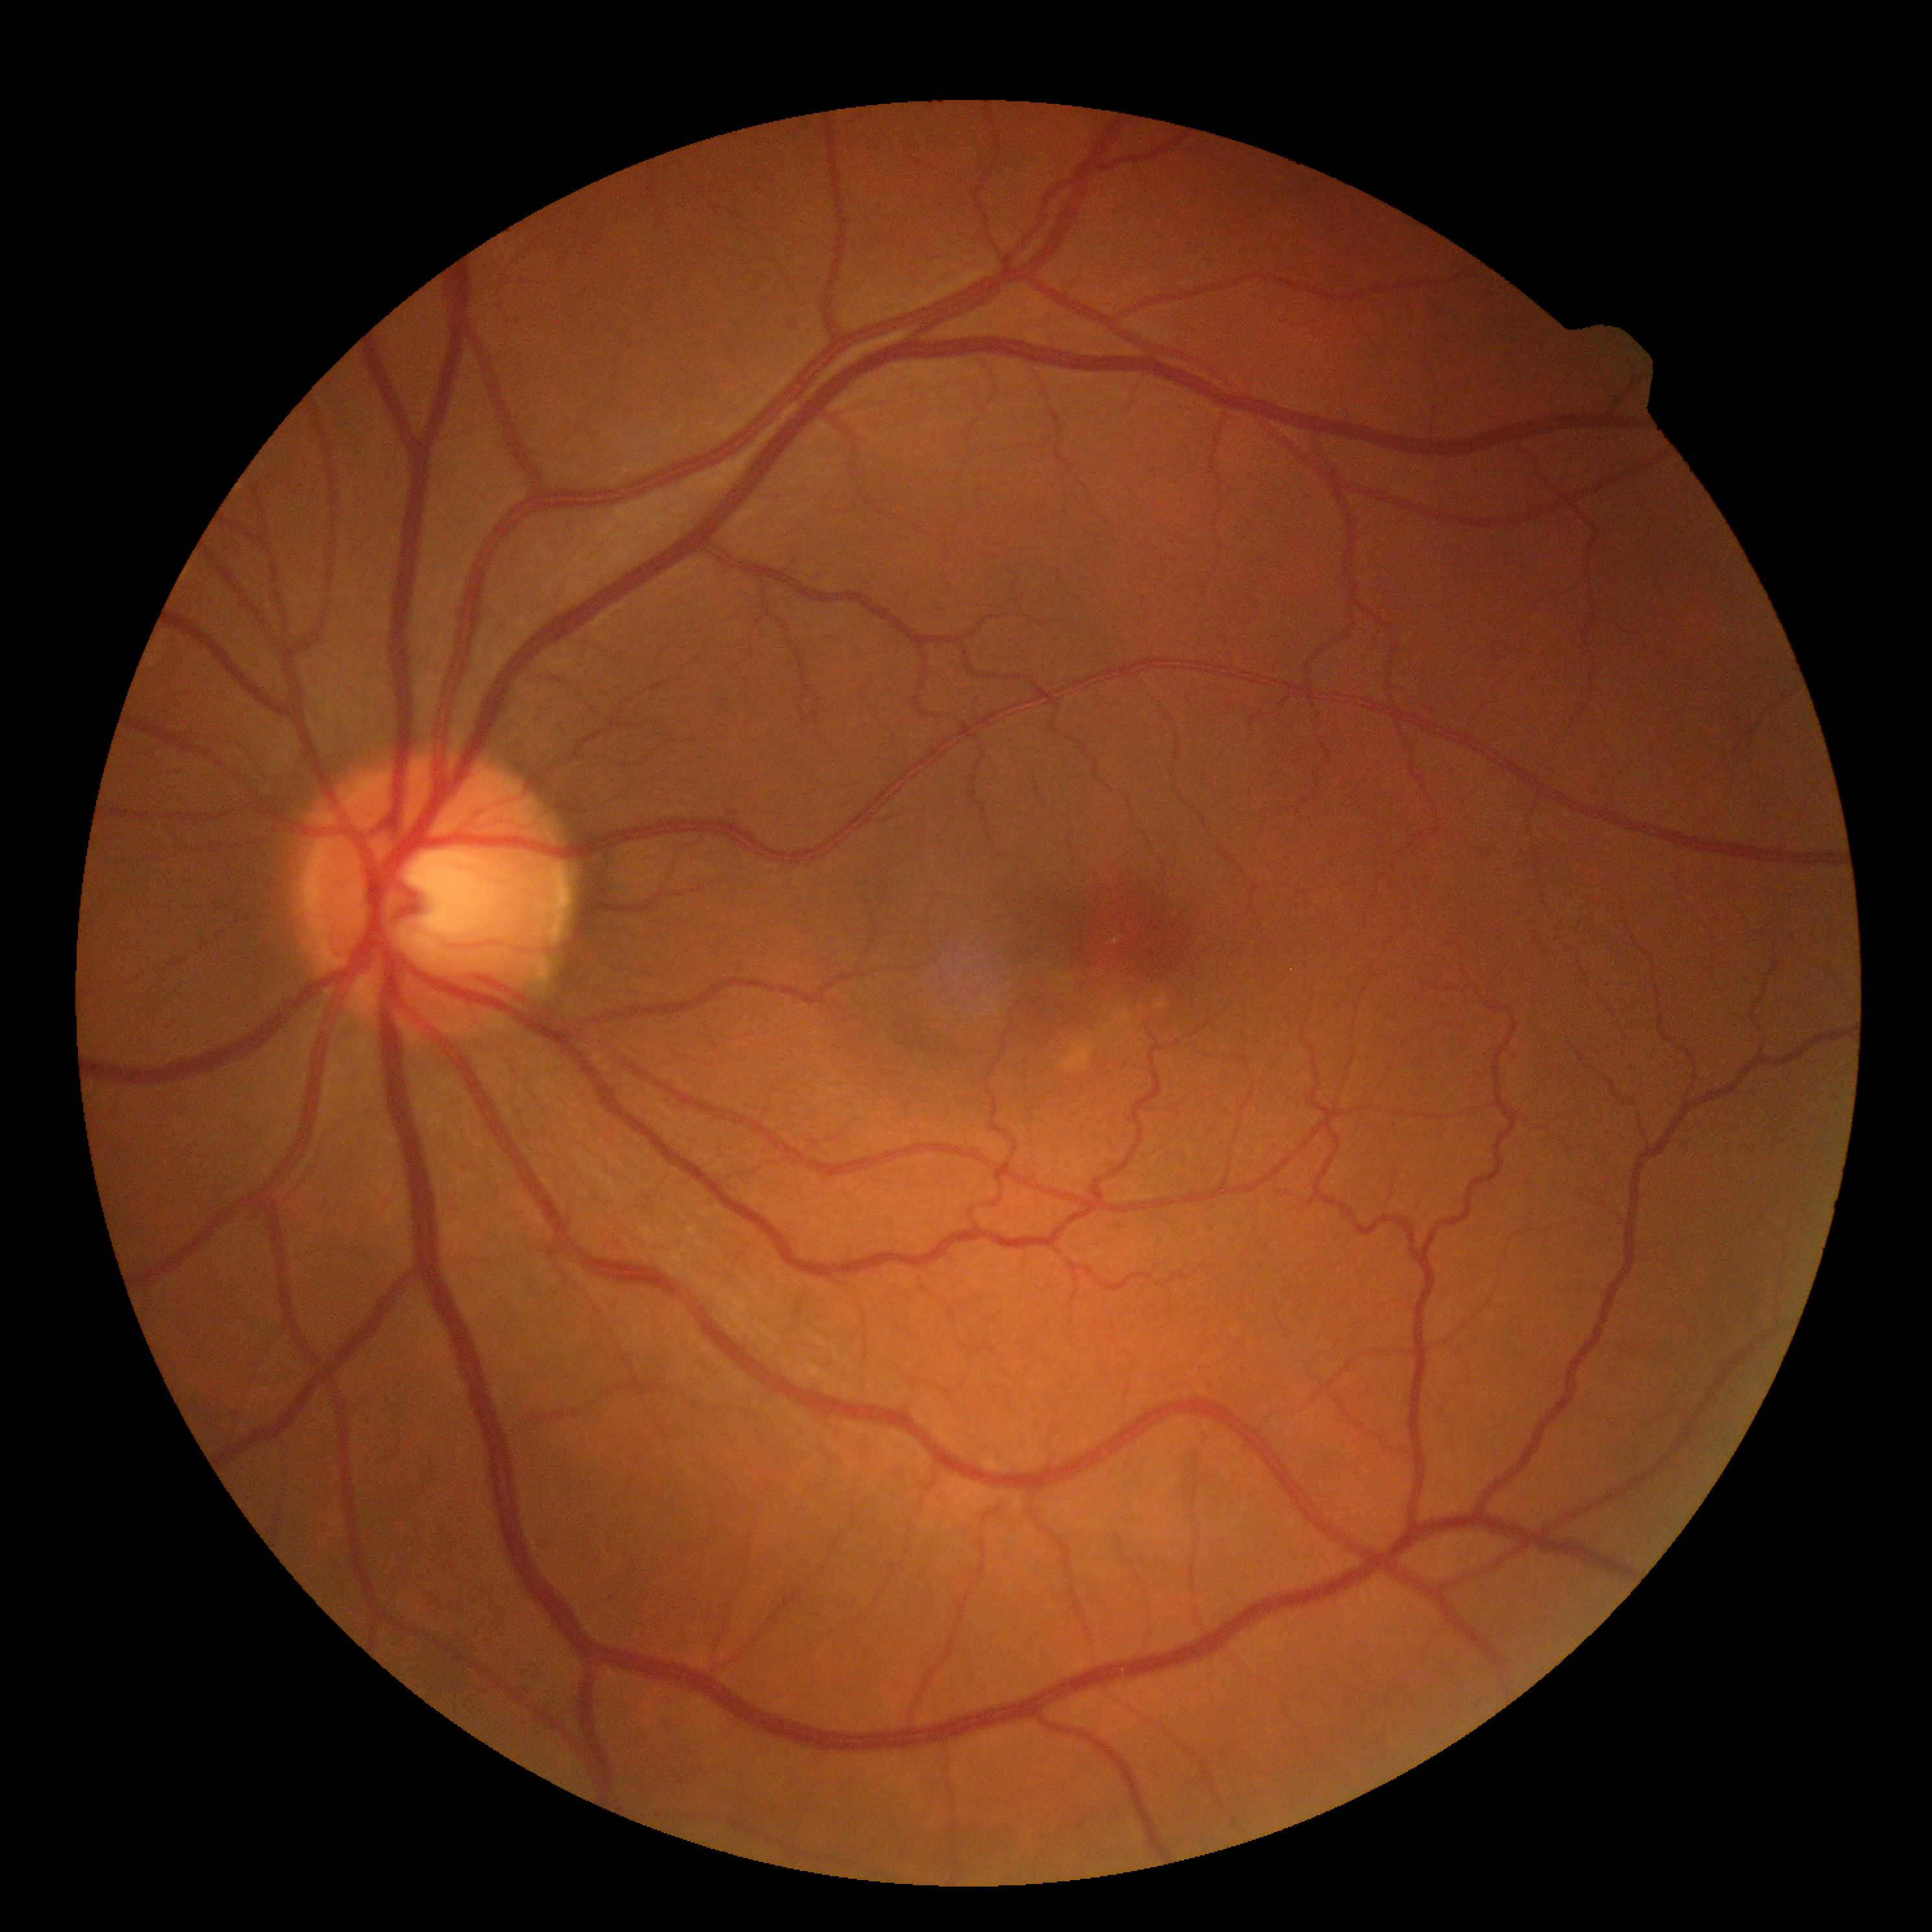

DR severity: grade 0.